Wide-field contact fundus photograph of an infant:
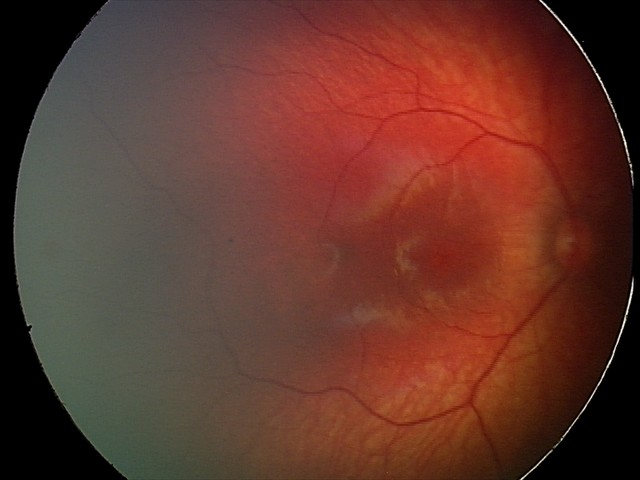
From an examination with diagnosis of retinal hemorrhages.